Color fundus image. 45° FOV.
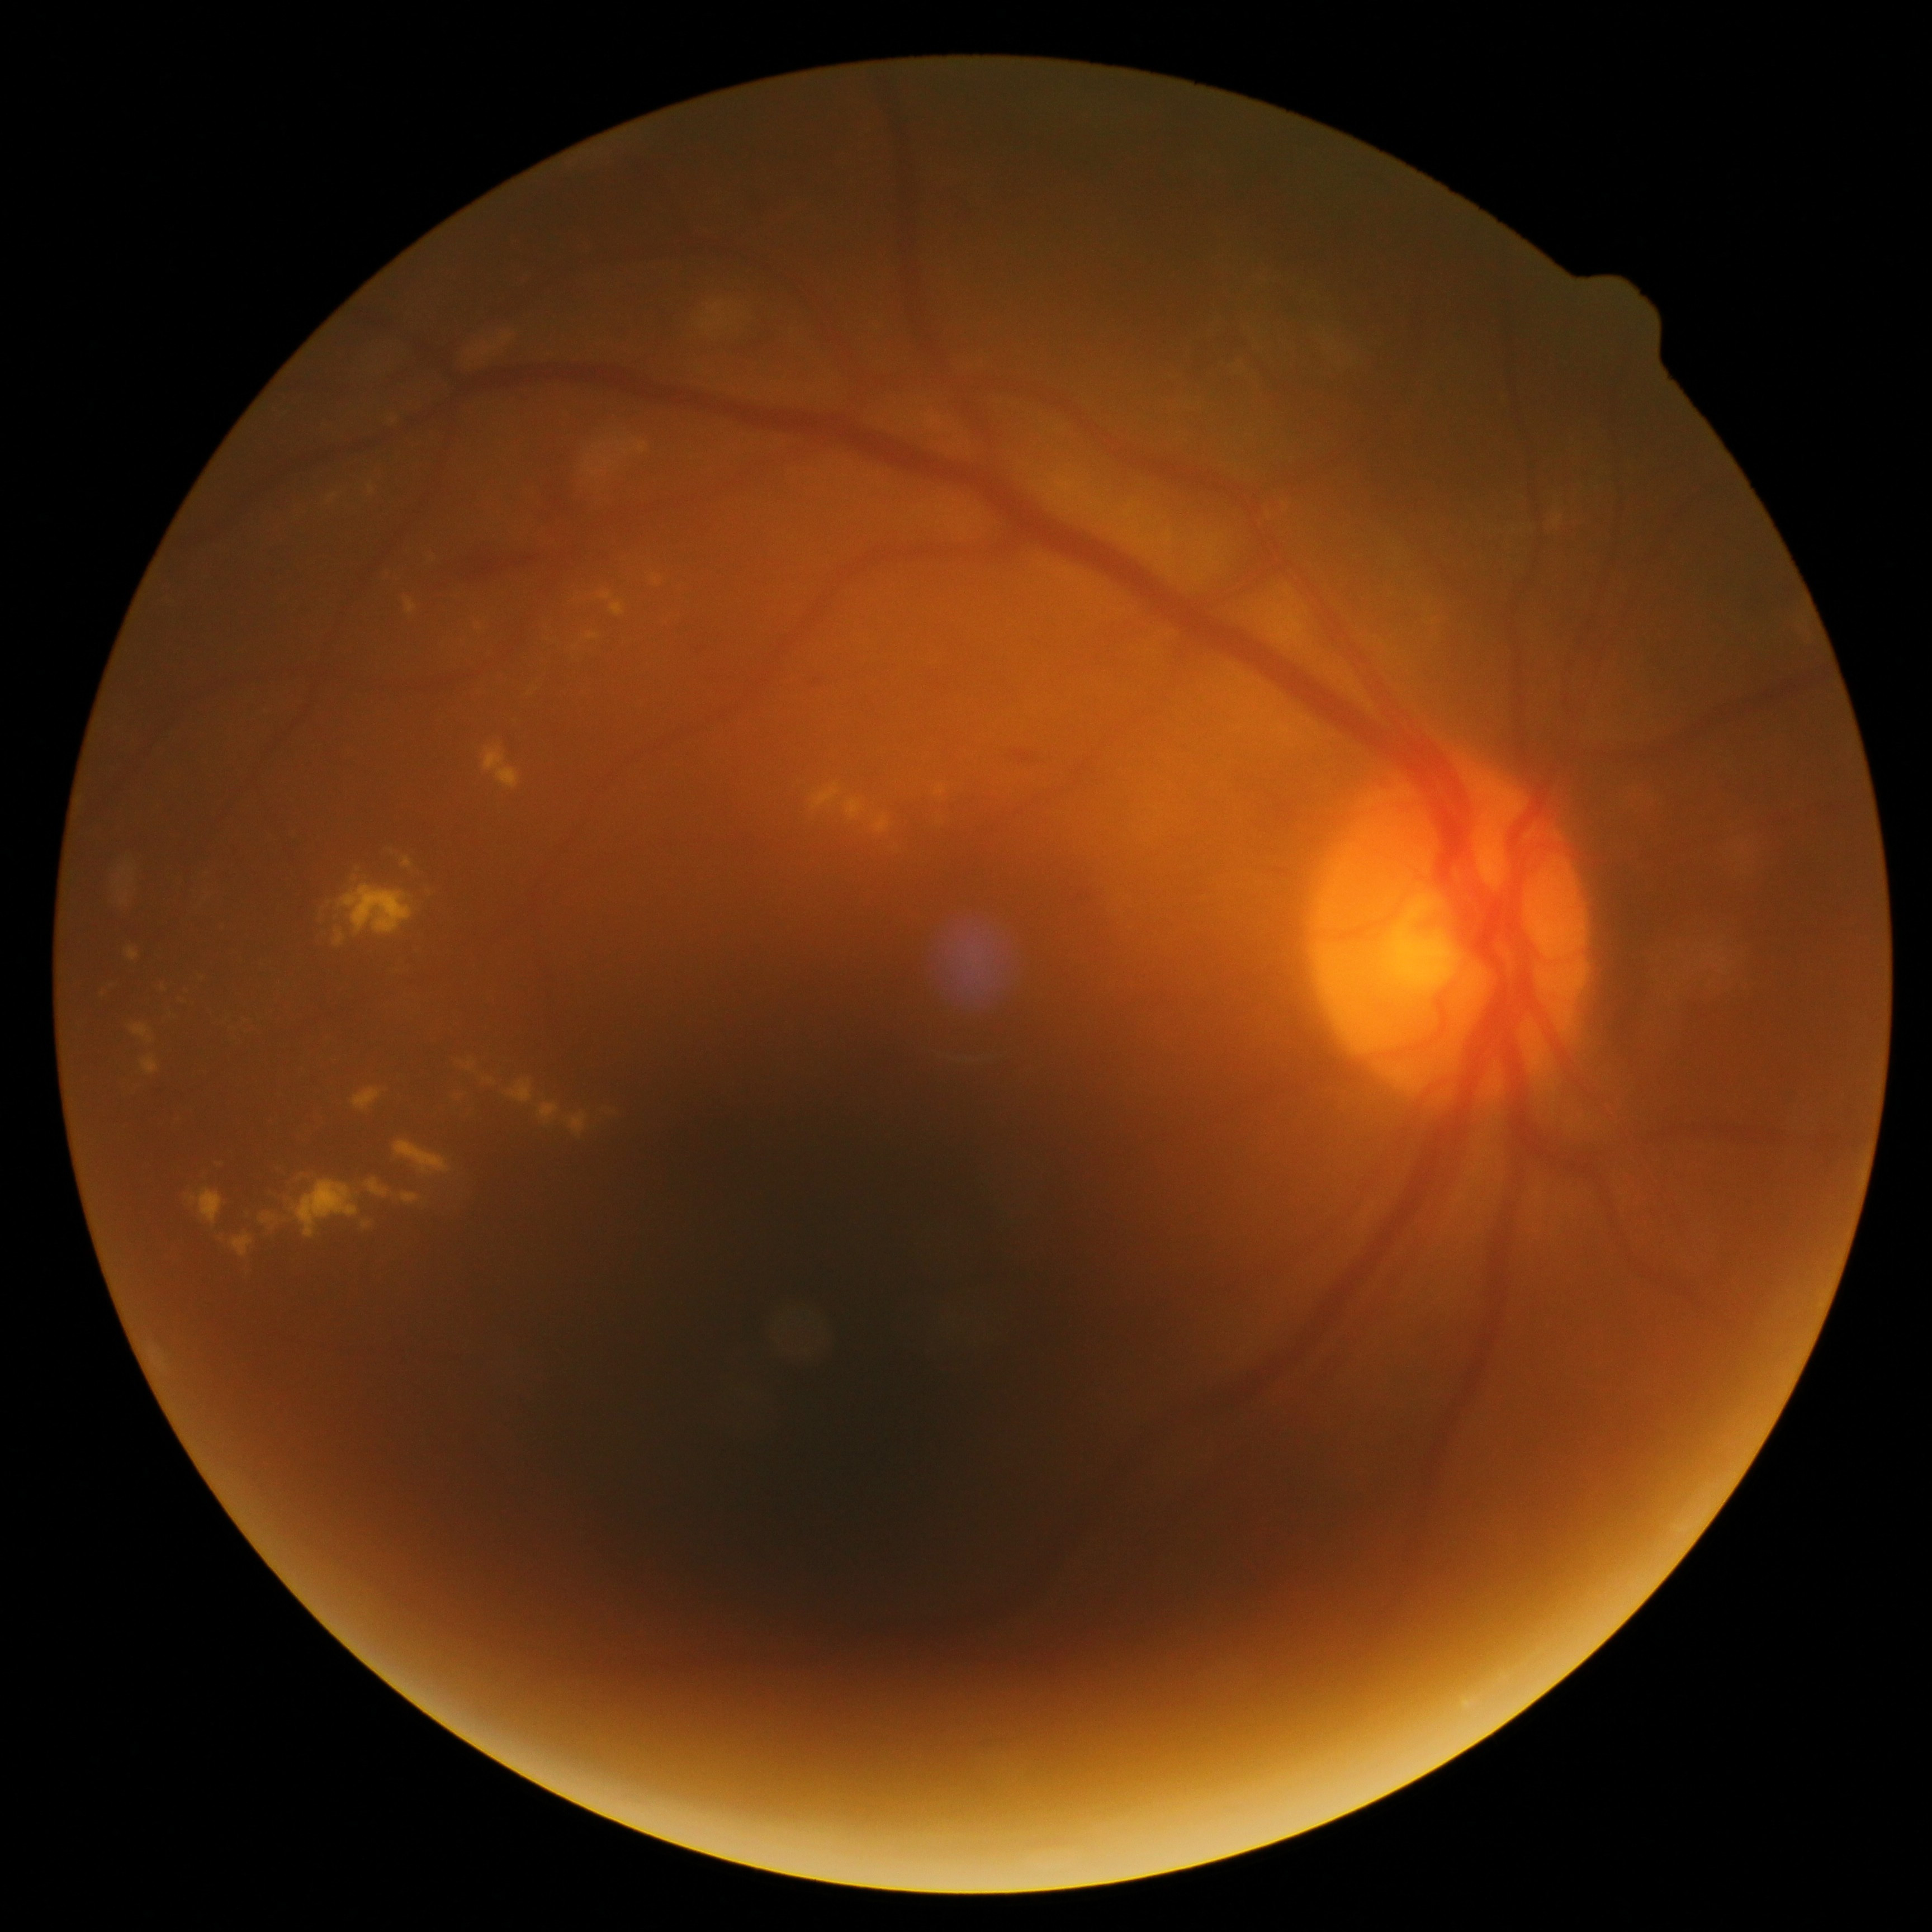 Diabetic retinopathy: moderate non-proliferative diabetic retinopathy (grade 2).